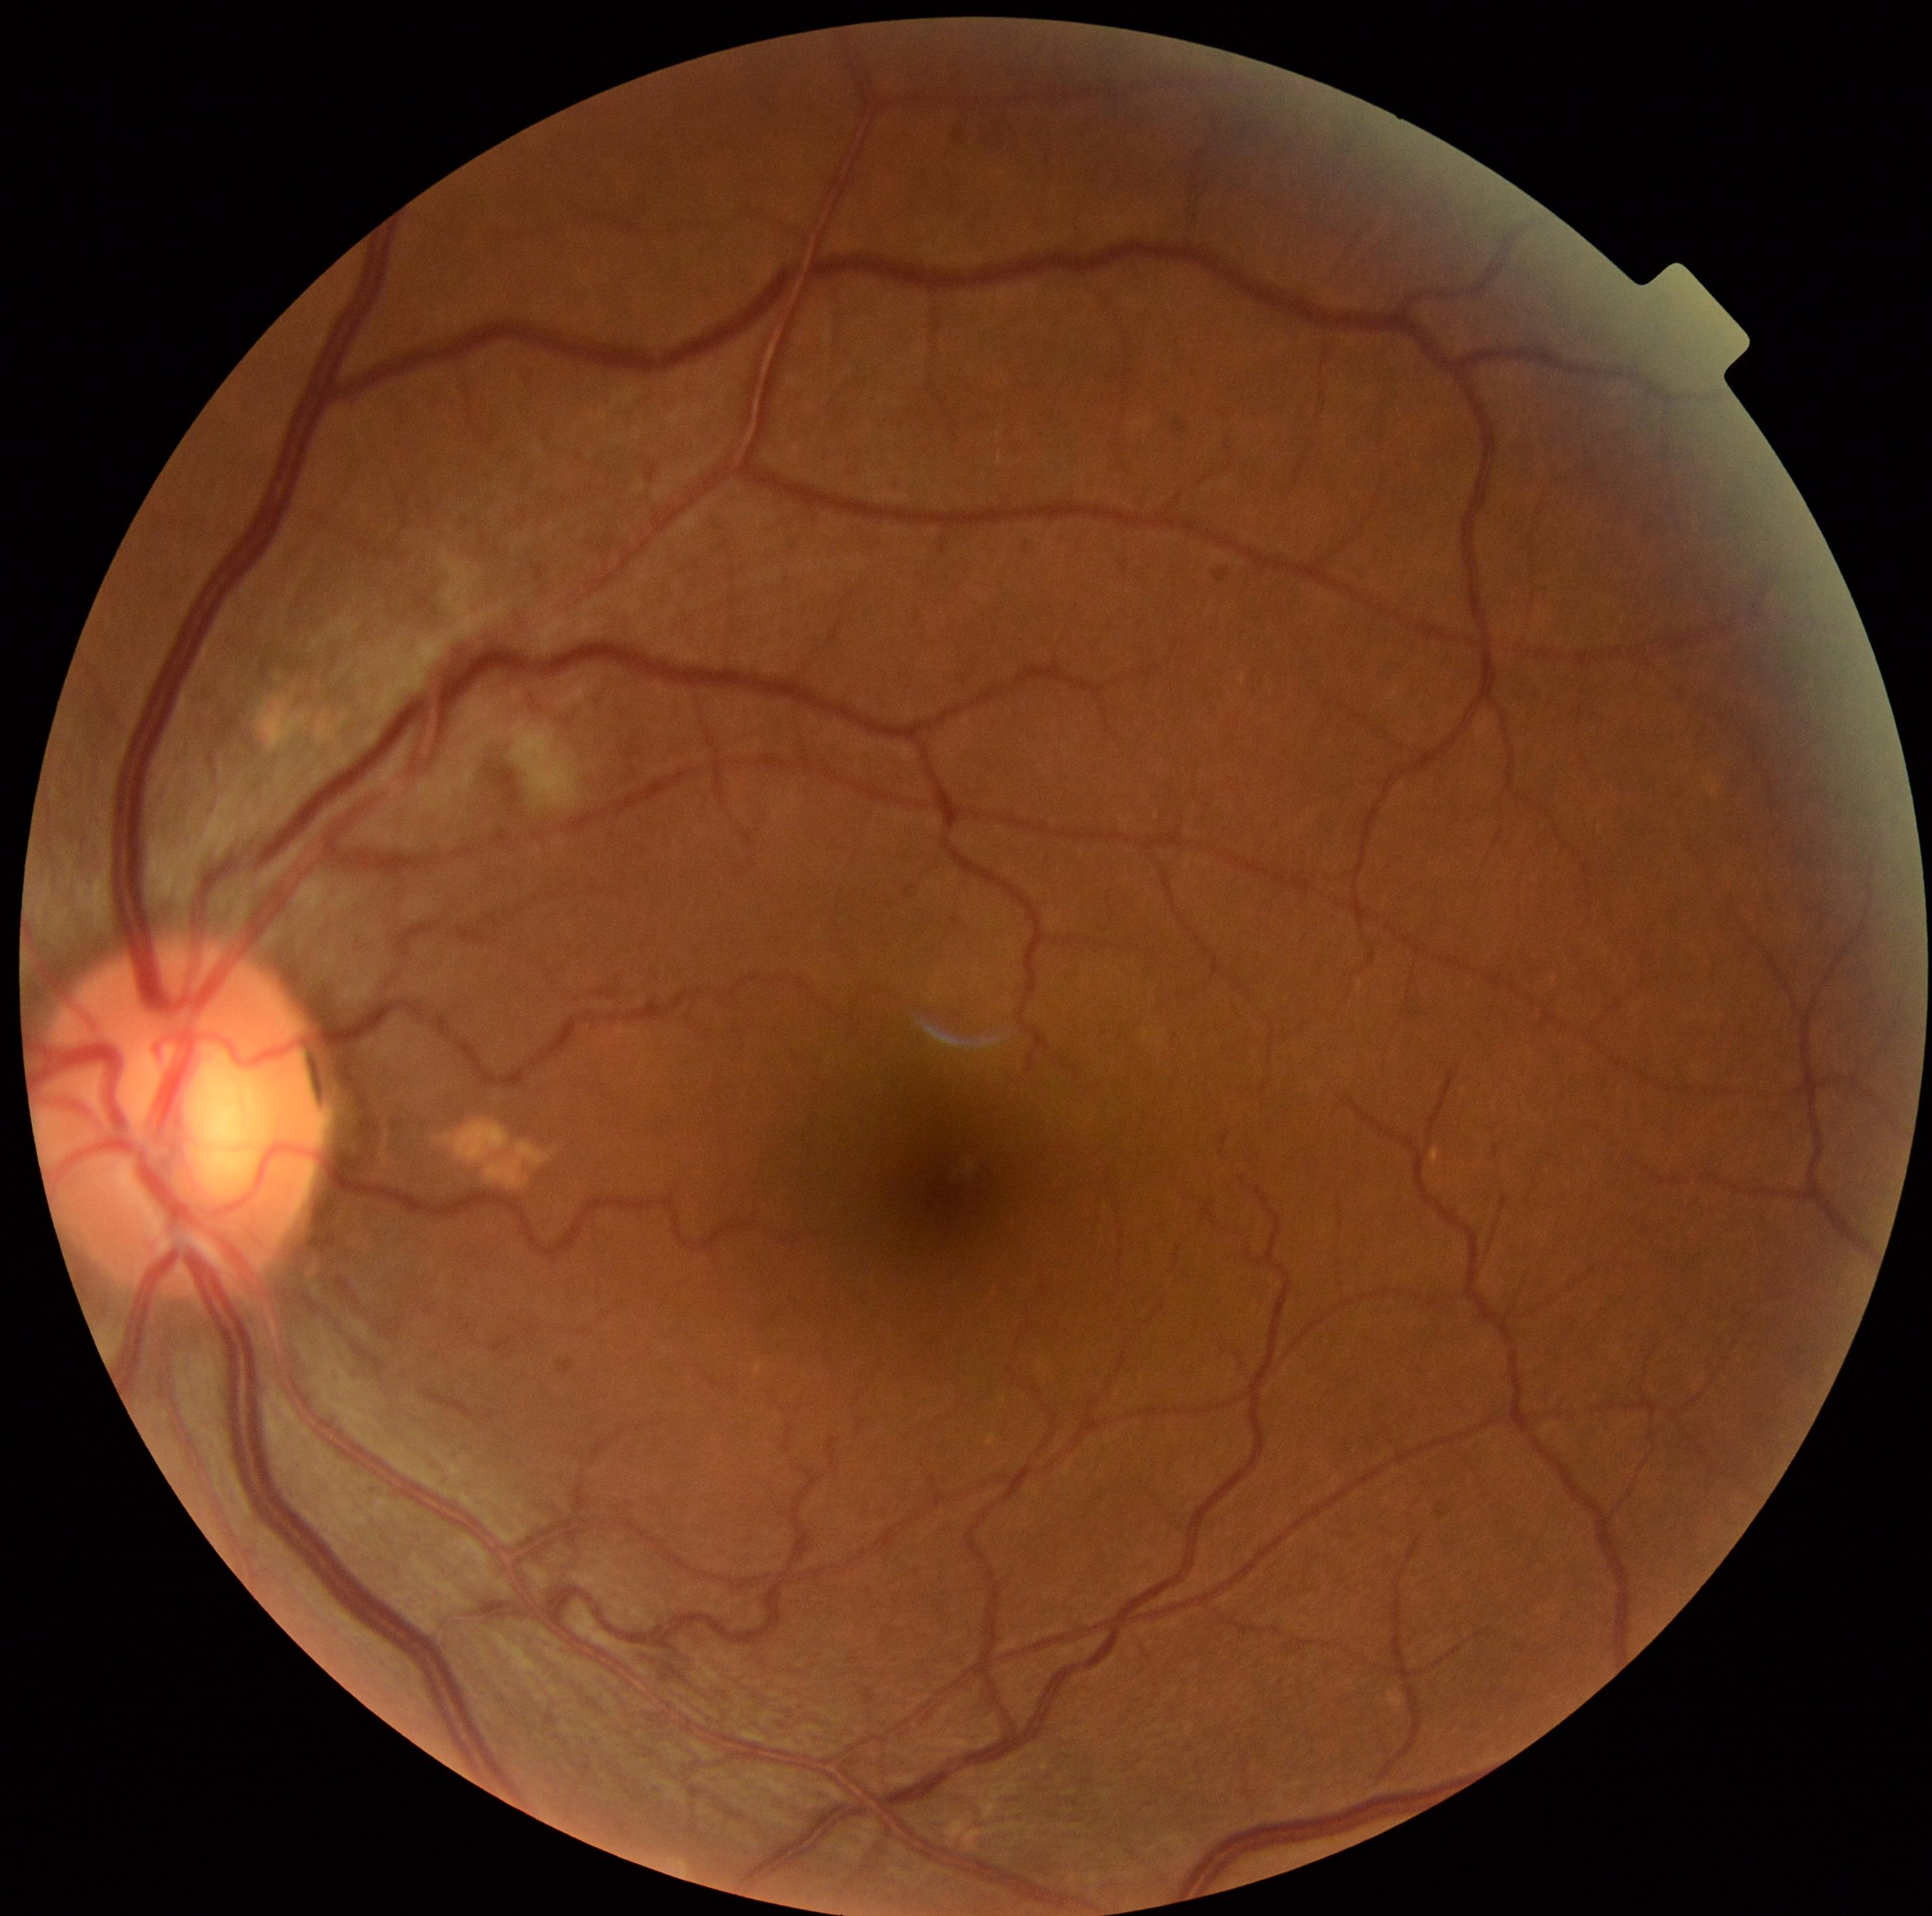

DR class: non-proliferative diabetic retinopathy. Diabetic retinopathy is 2/4.